DR severity per modified Davis staging. 848x848. 45° FOV.
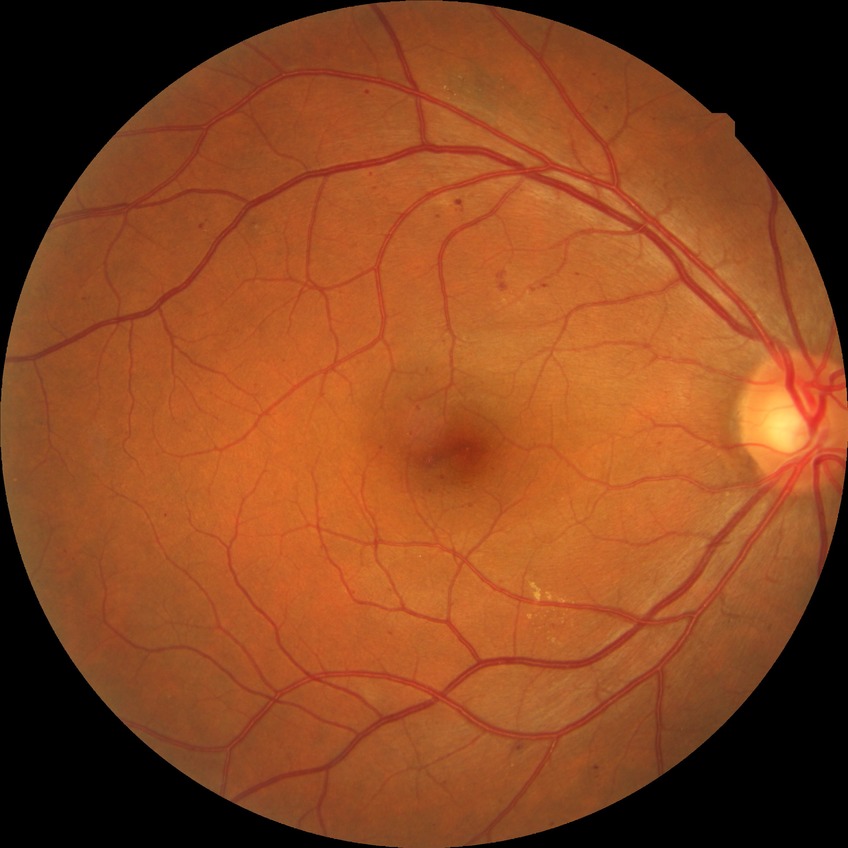

Davis grading: simple diabetic retinopathy.